Pediatric retinal photograph (wide-field) — 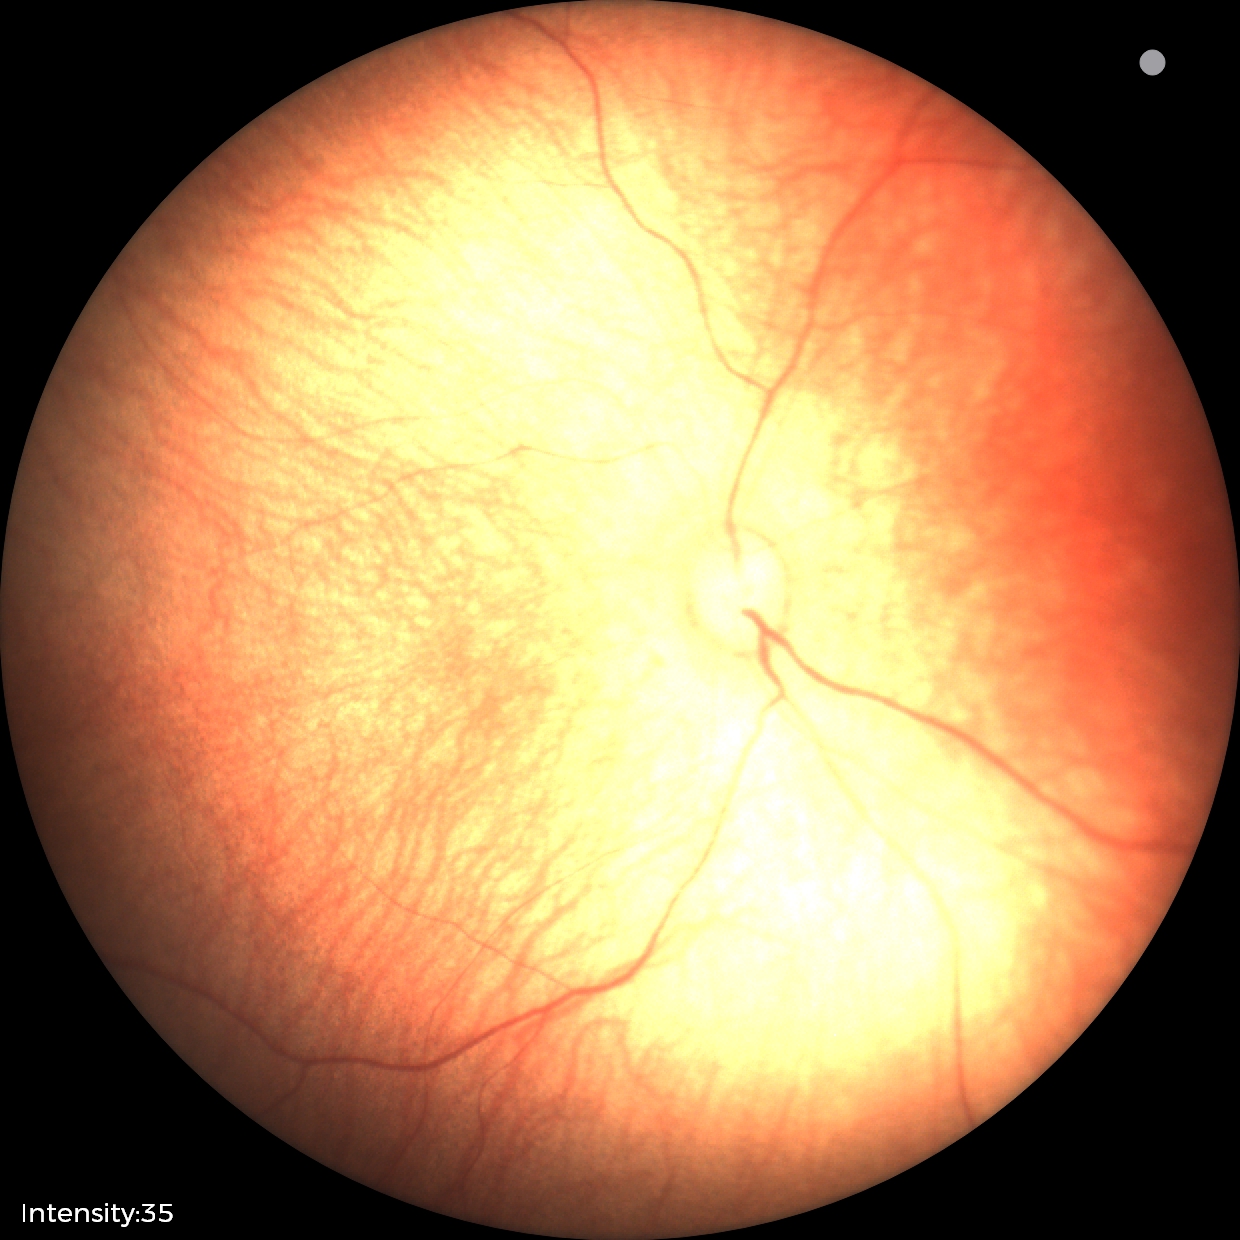

Impression: no pathology identified.